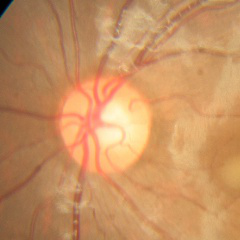
Impression: no evidence of glaucoma.